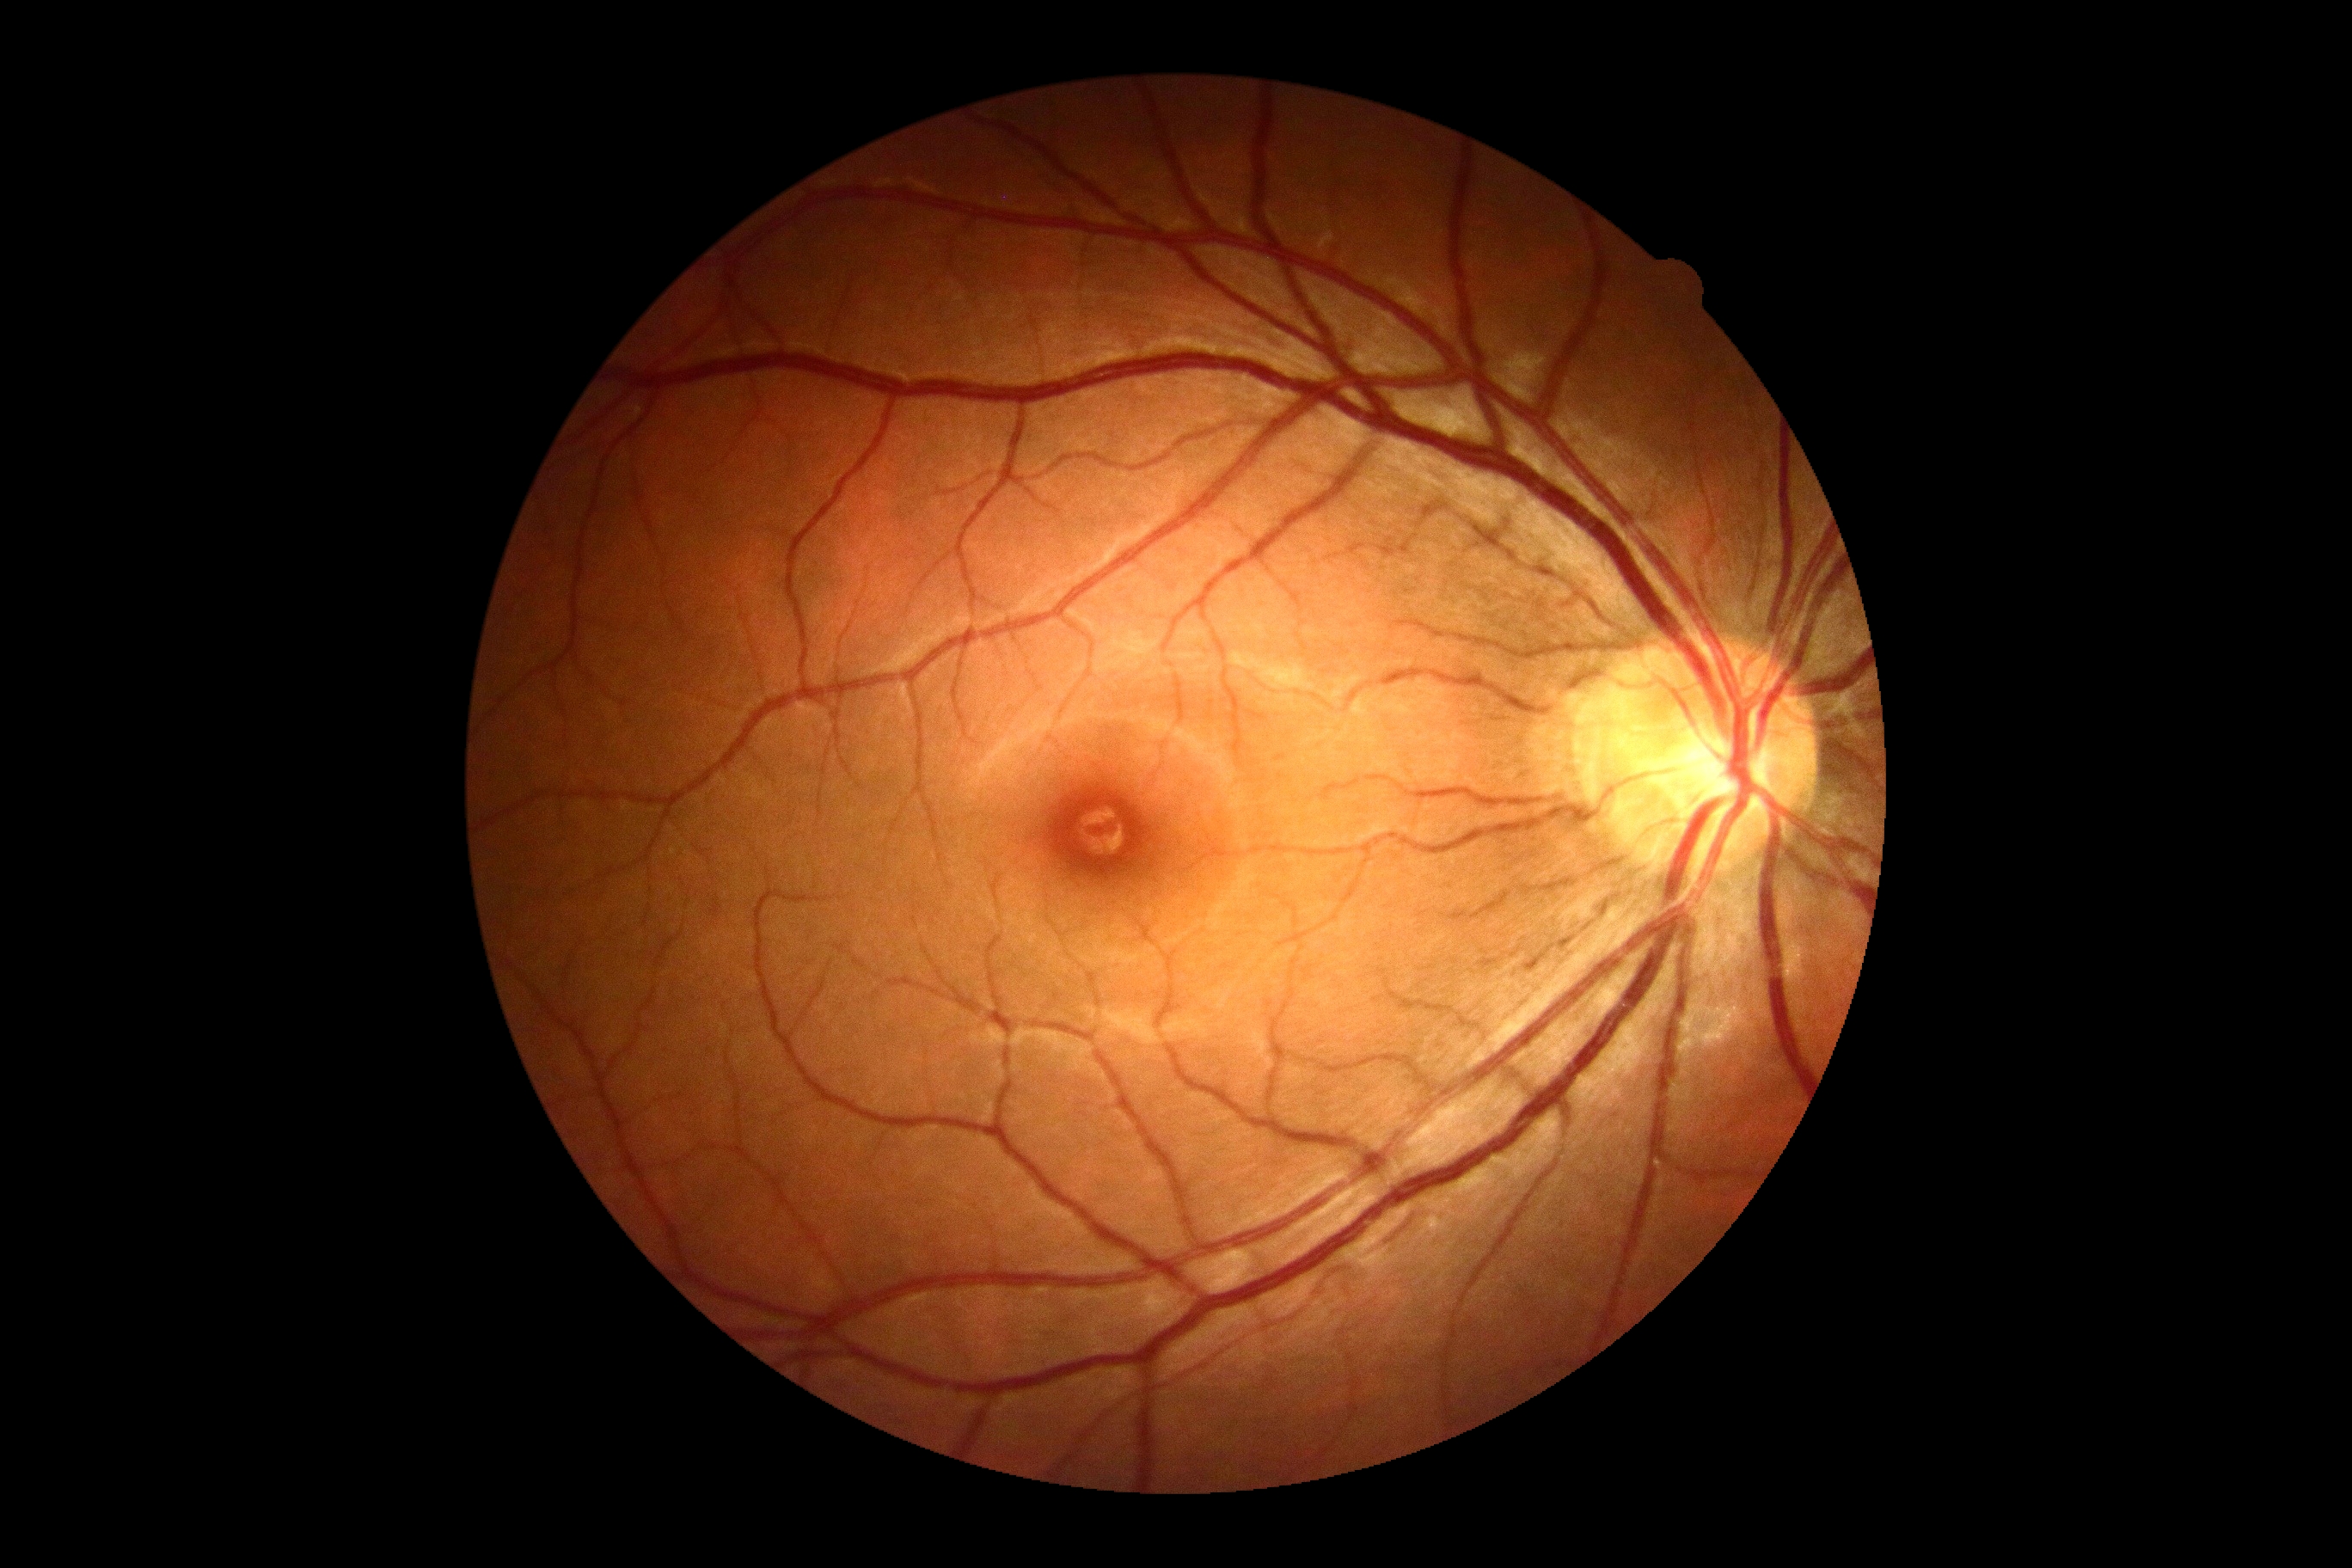
DR: grade 0.